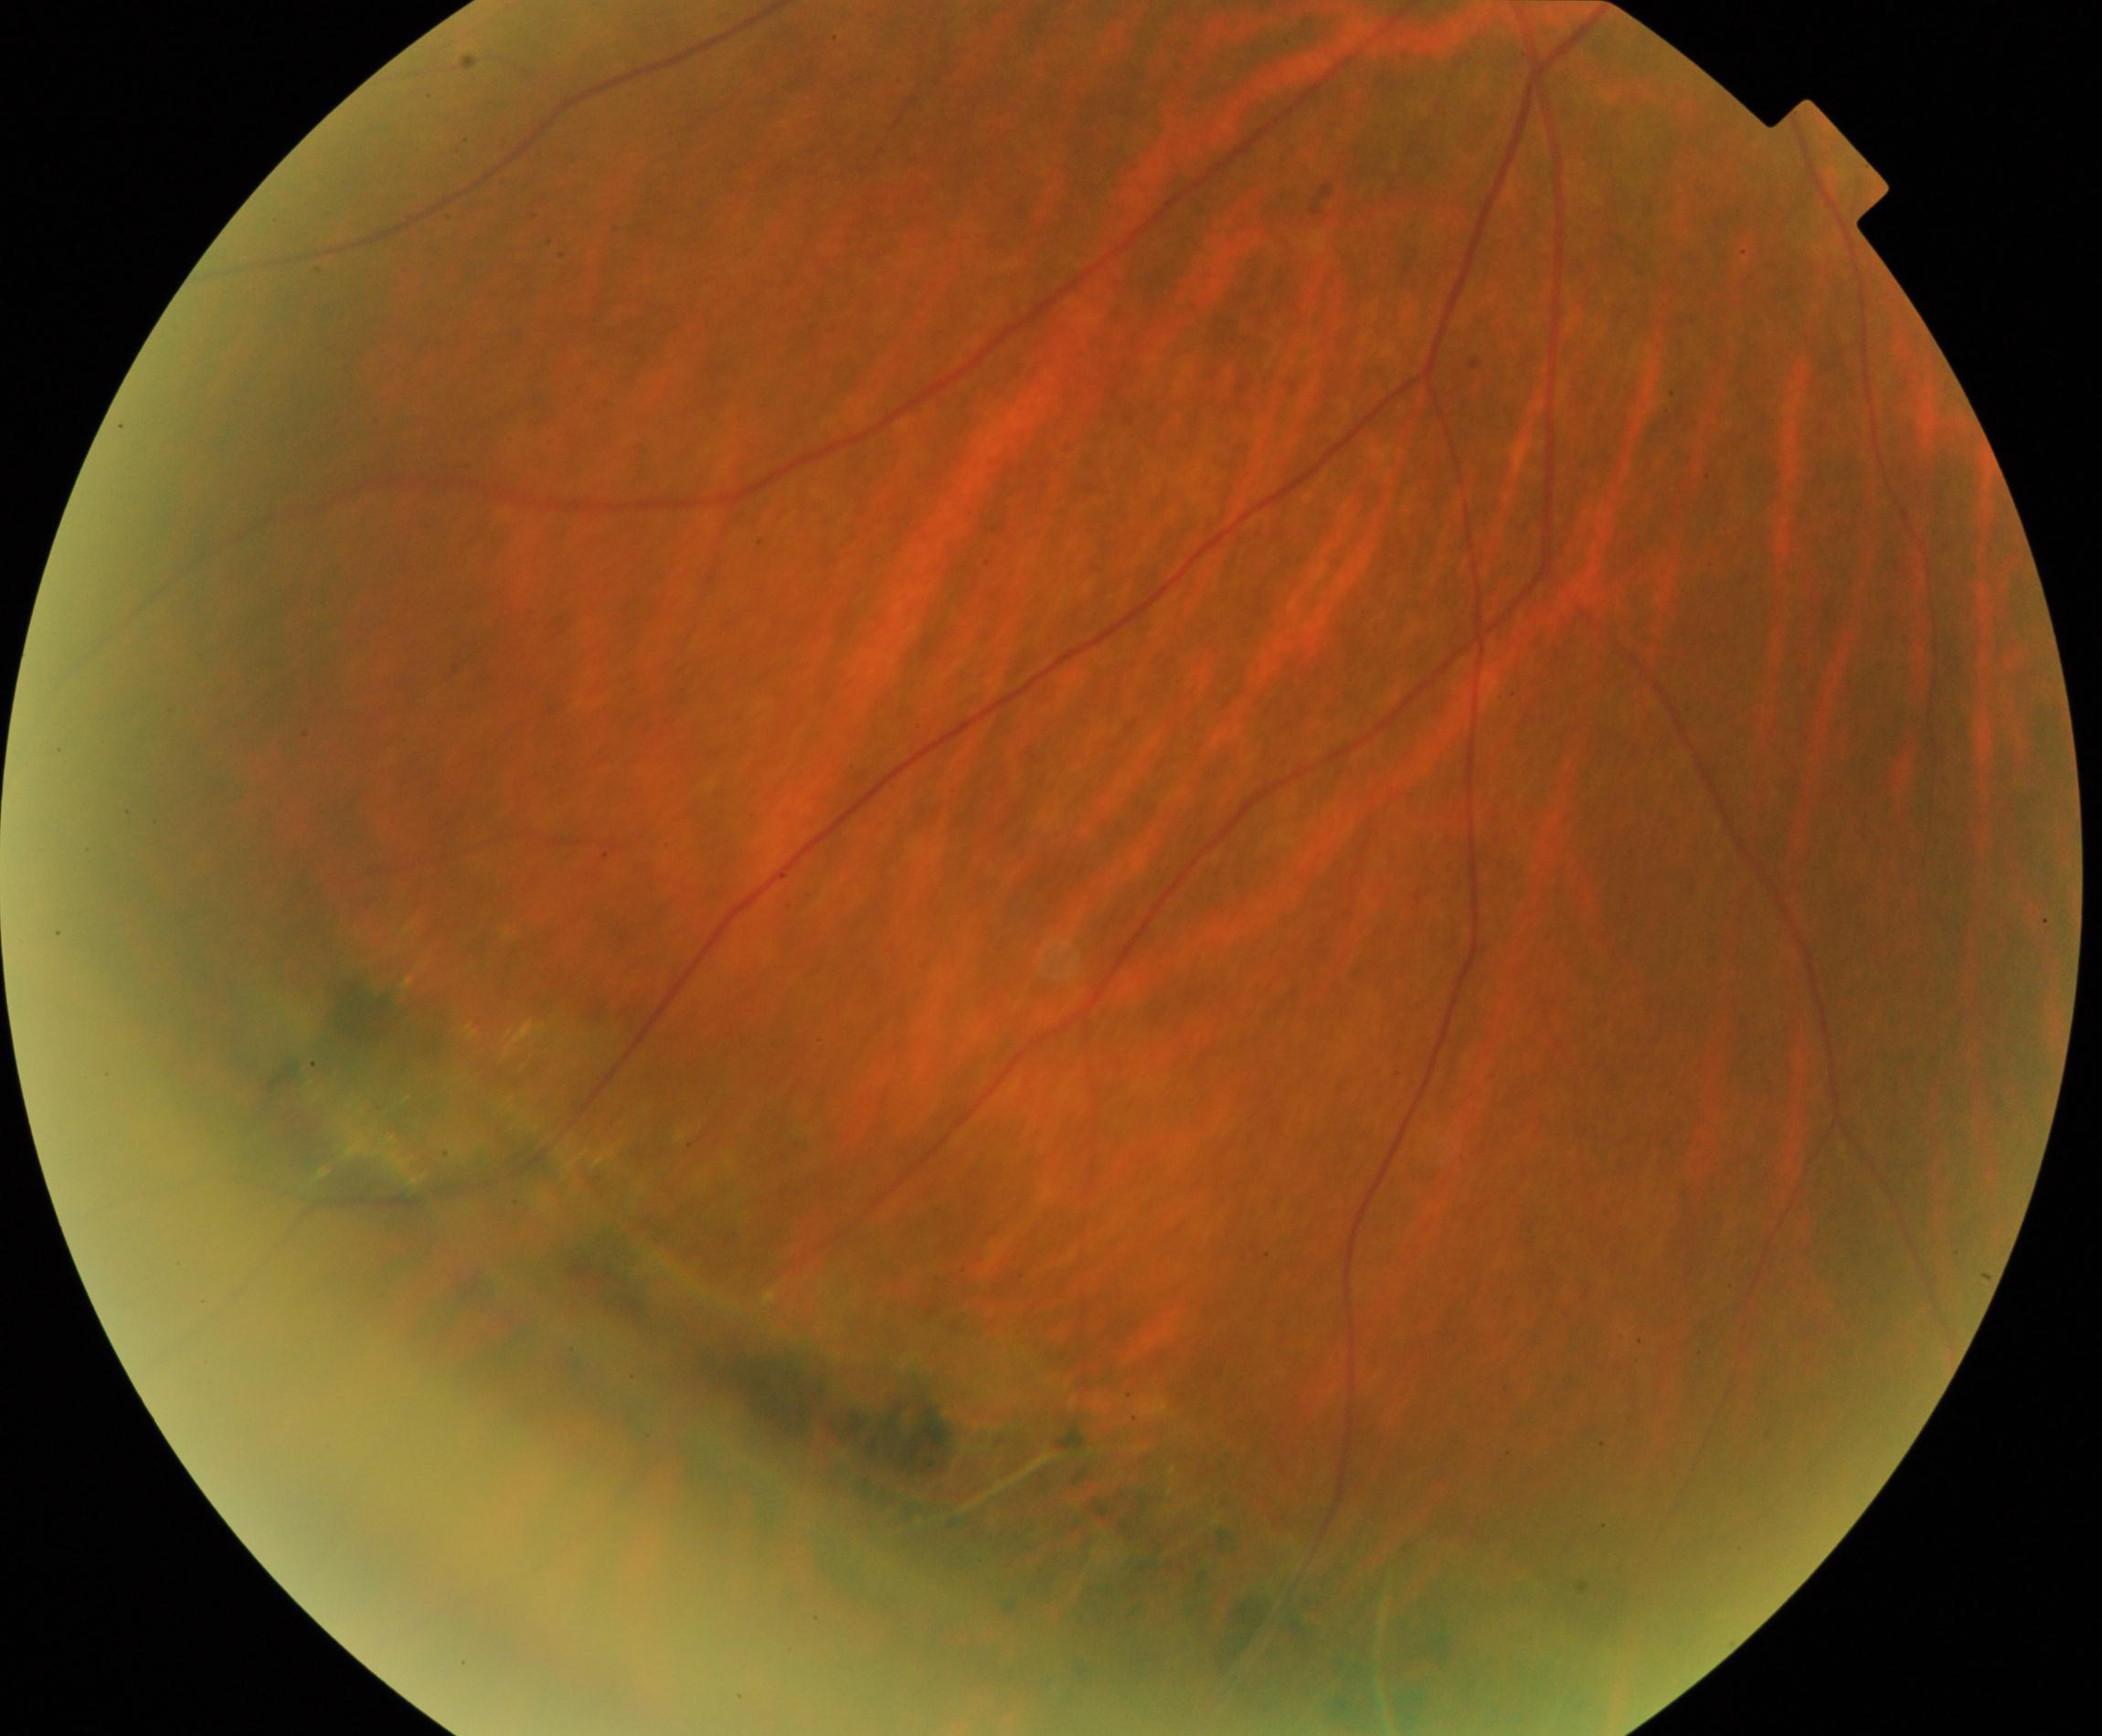
Consistent with peripheral retinal degeneration and break.